Wide-field fundus photograph of an infant; camera: Phoenix ICON (100° FOV); 1240 by 1240 pixels: 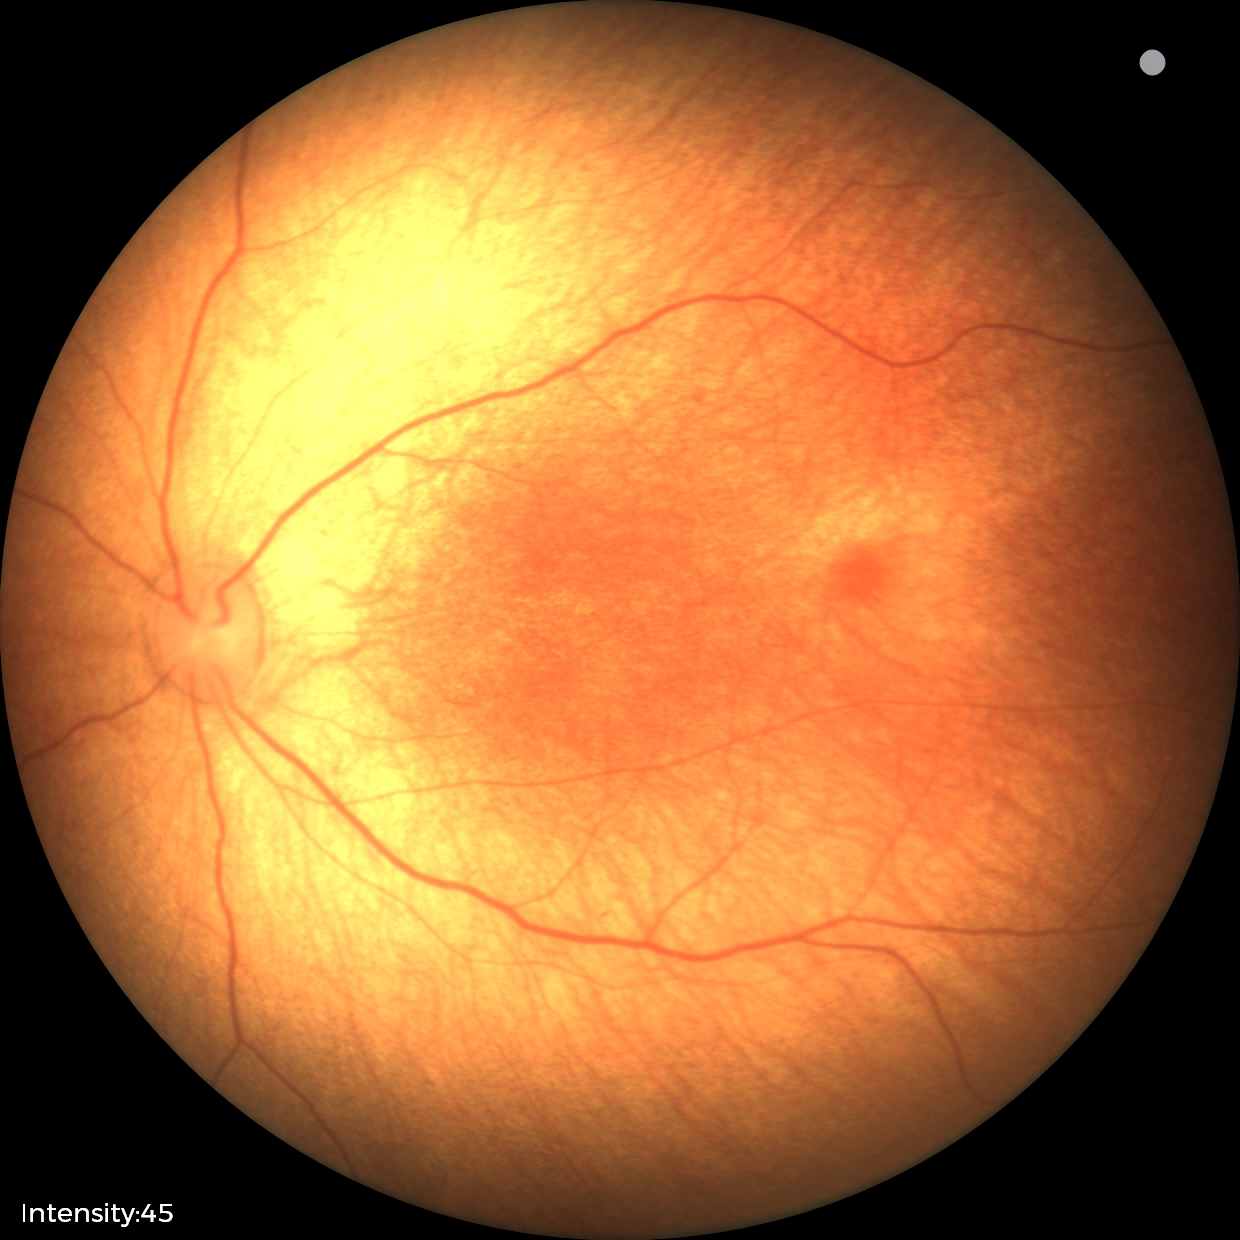 Screening examination with no abnormal retinal findings.